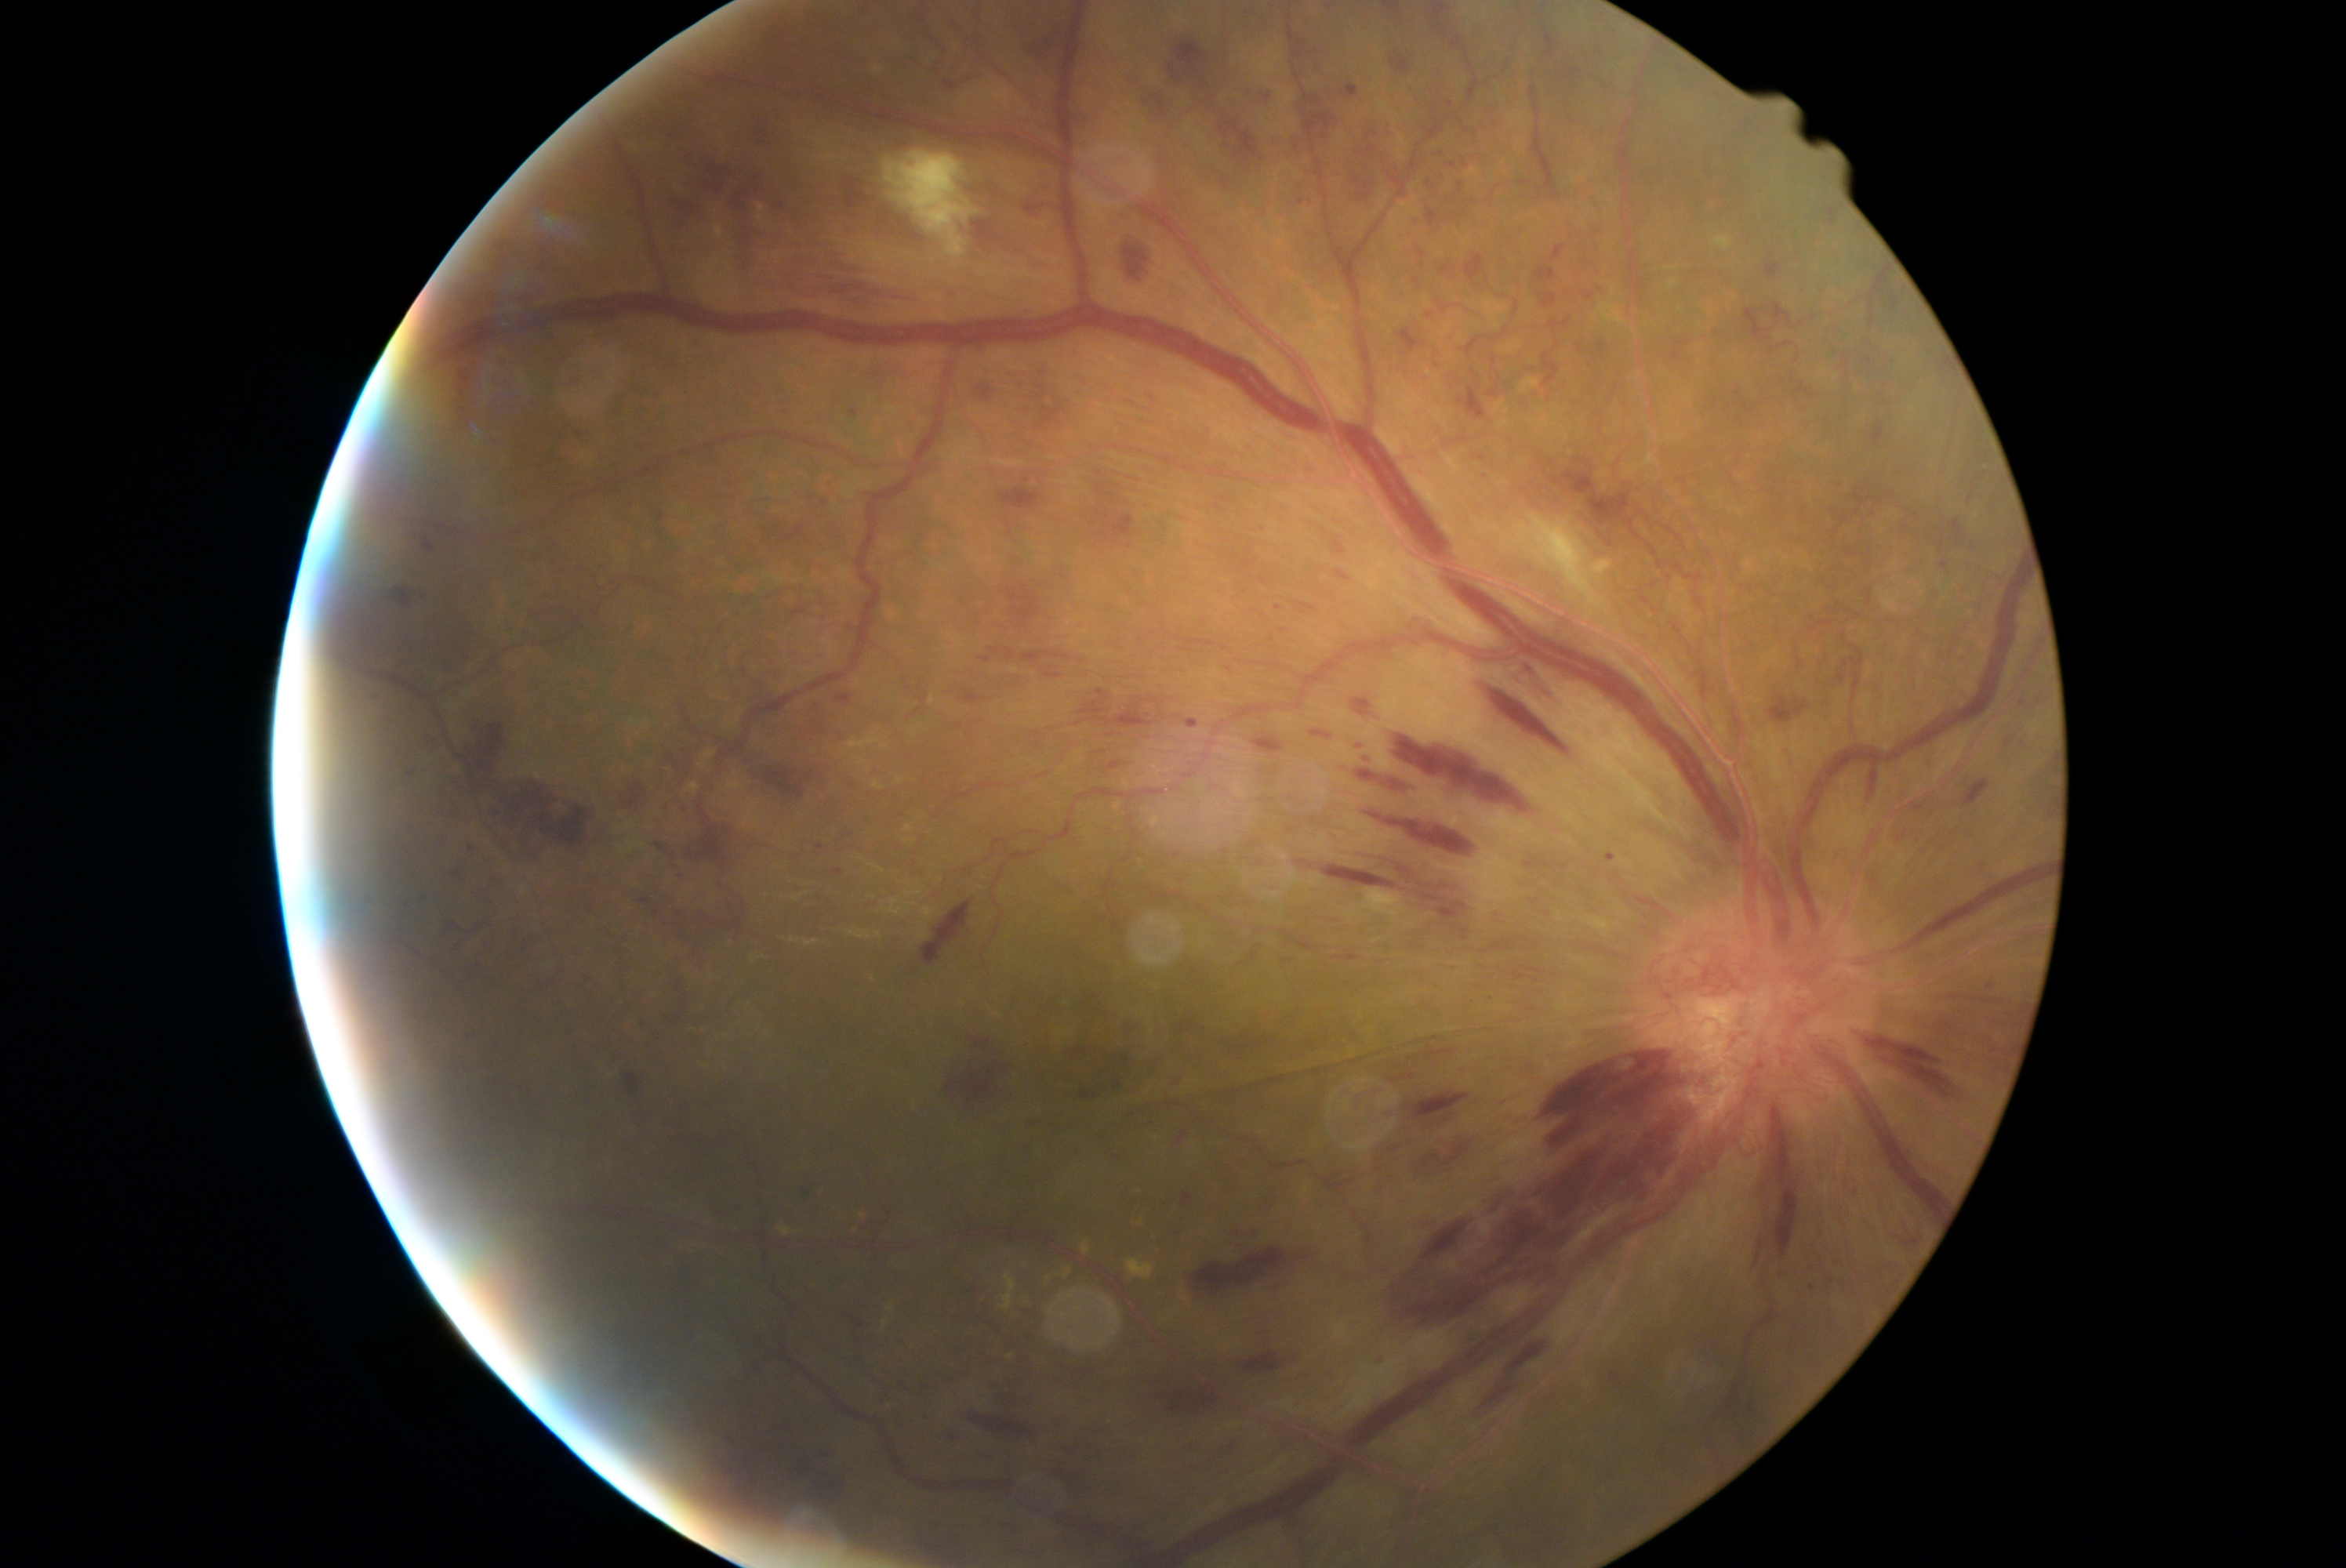

{"partial":true,"dr_grade":4,"lesions":{"he":[[1221,178,1233,189],[1414,275,1422,289],[1240,1352,1287,1374],[1771,1105,1799,1258],[1034,366,1072,435],[1356,742,1375,764],[851,410,859,416],[1348,771,1422,797],[1458,183,1464,195],[1291,137,1306,156],[1415,1145,1465,1172],[978,387,993,401],[1585,945,1625,959],[1382,1261,1491,1330],[1177,1131,1189,1145],[1550,244,1567,264],[1464,253,1489,283]],"he_small_centers":[[1404,353],[1483,458],[1812,1287]]}}